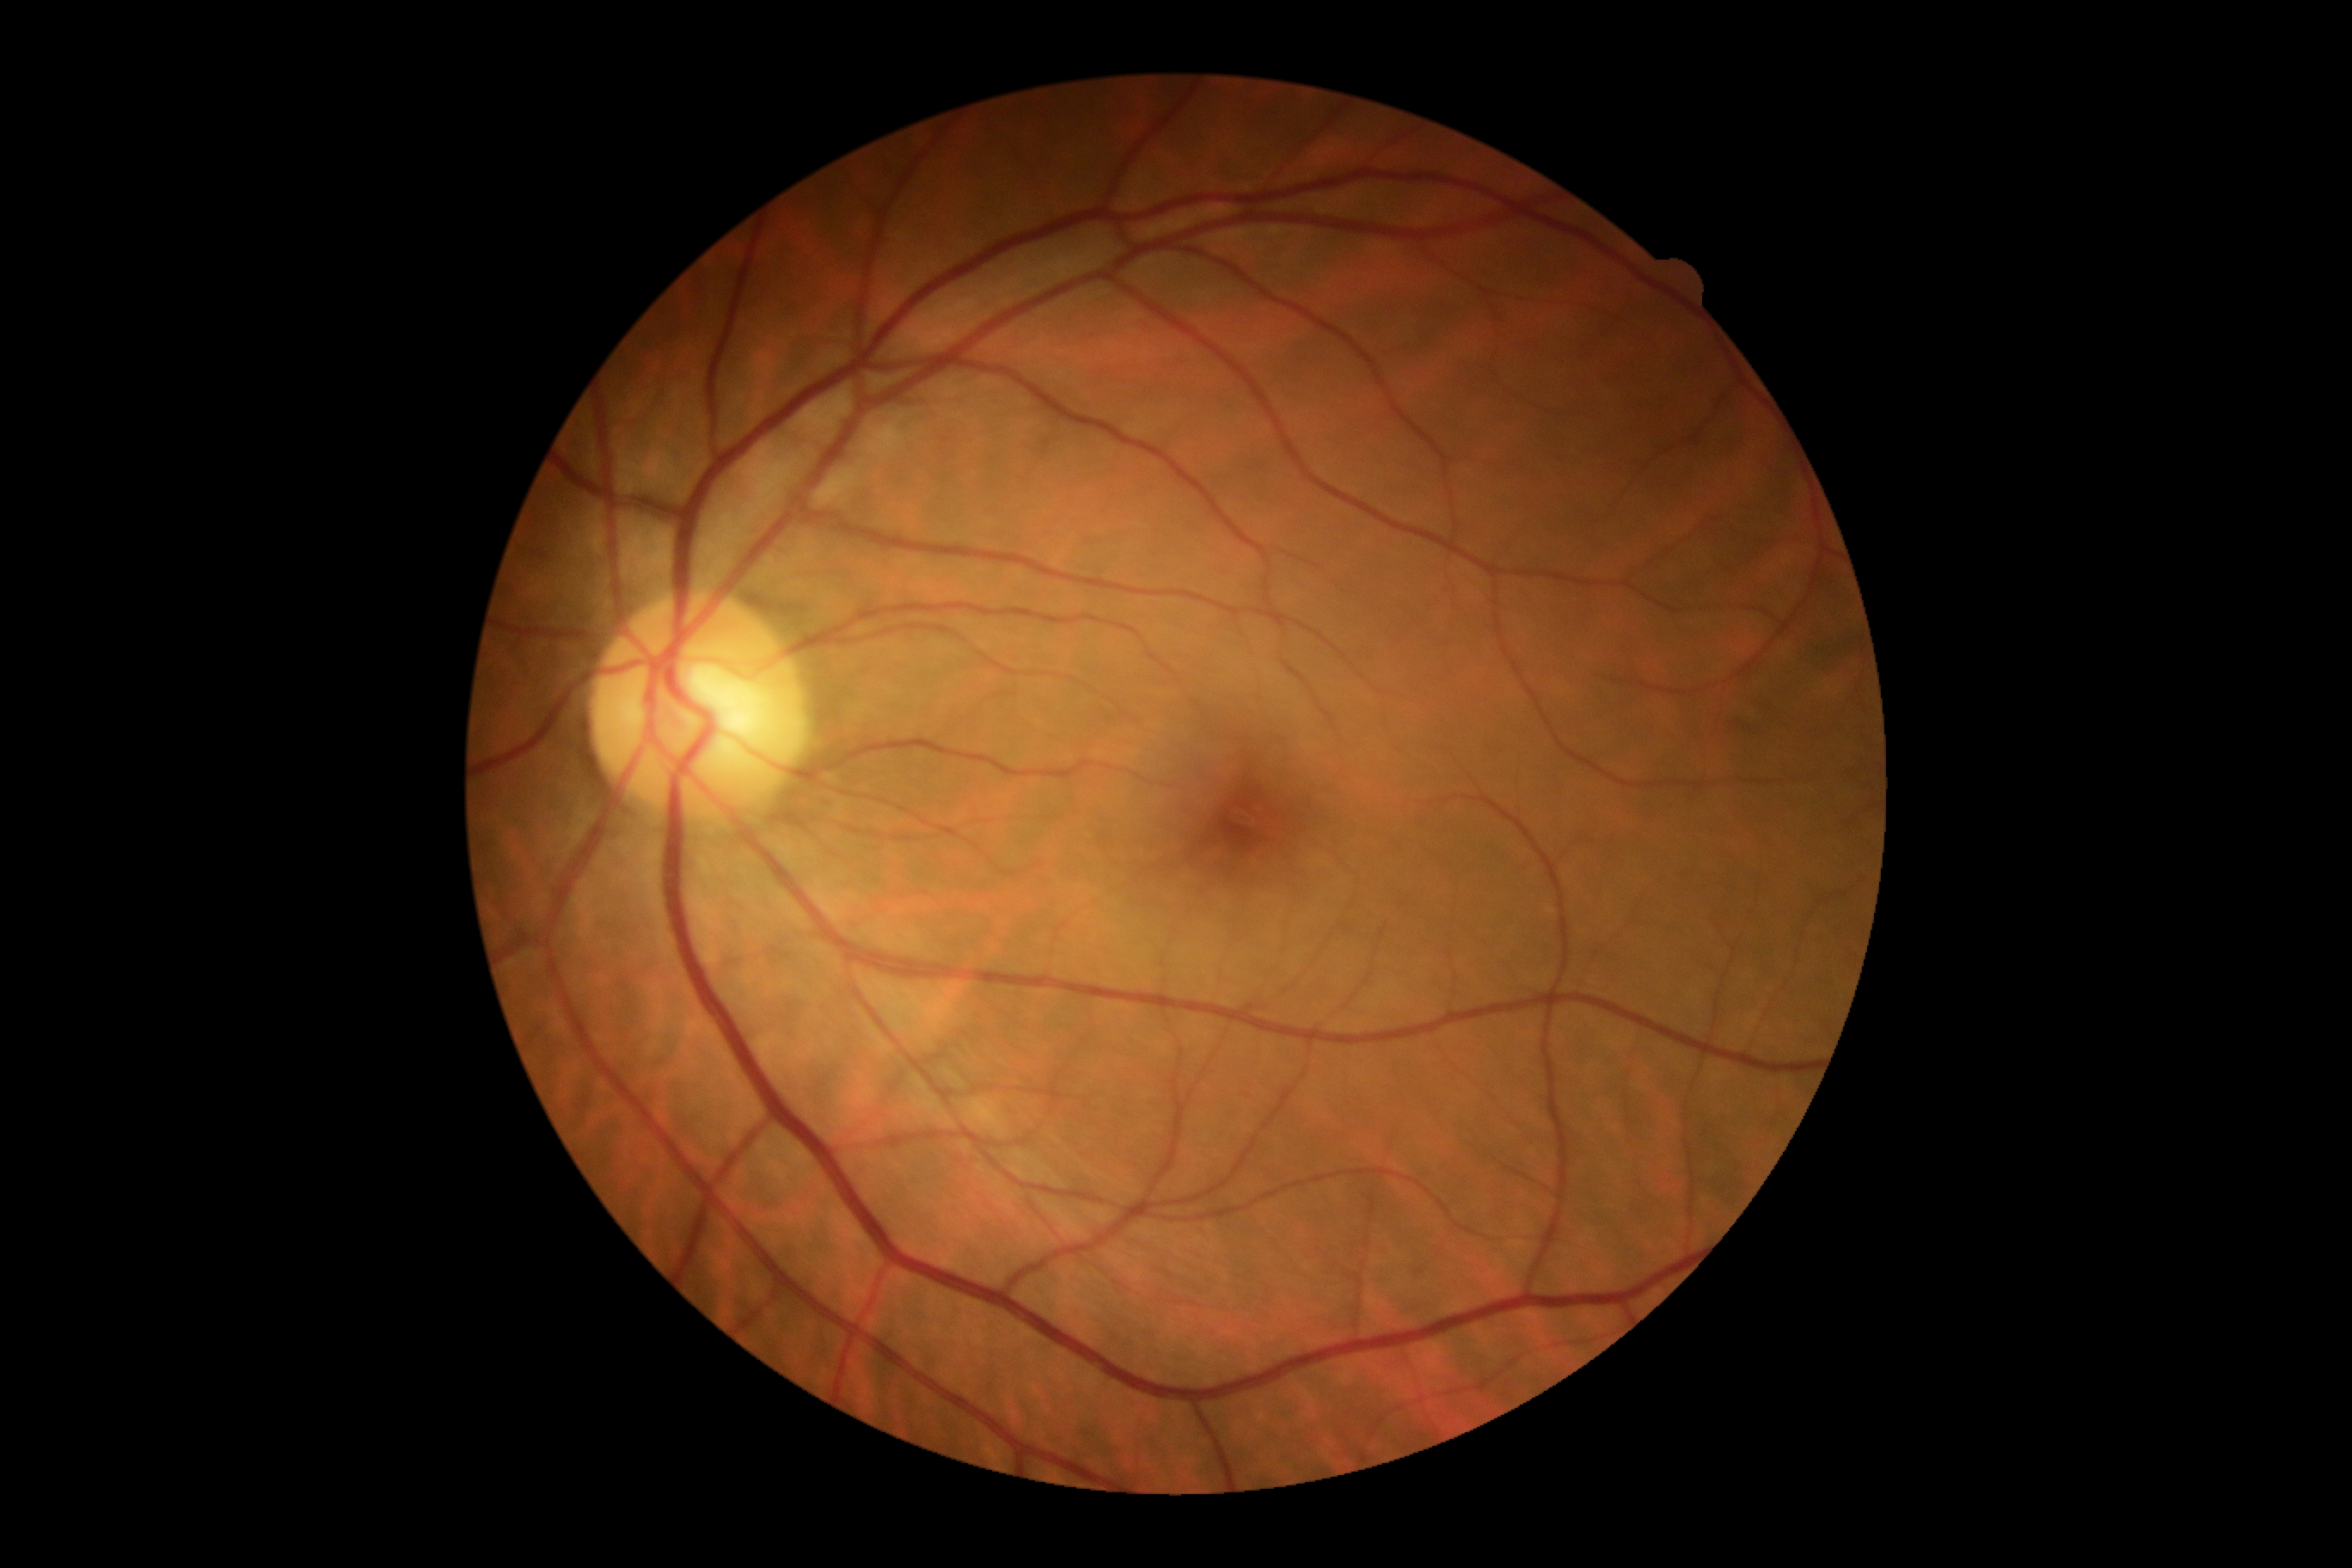

{
  "dr_grade": "no apparent diabetic retinopathy (grade 0)",
  "dr_impression": "negative for DR"
}